45-degree field of view — 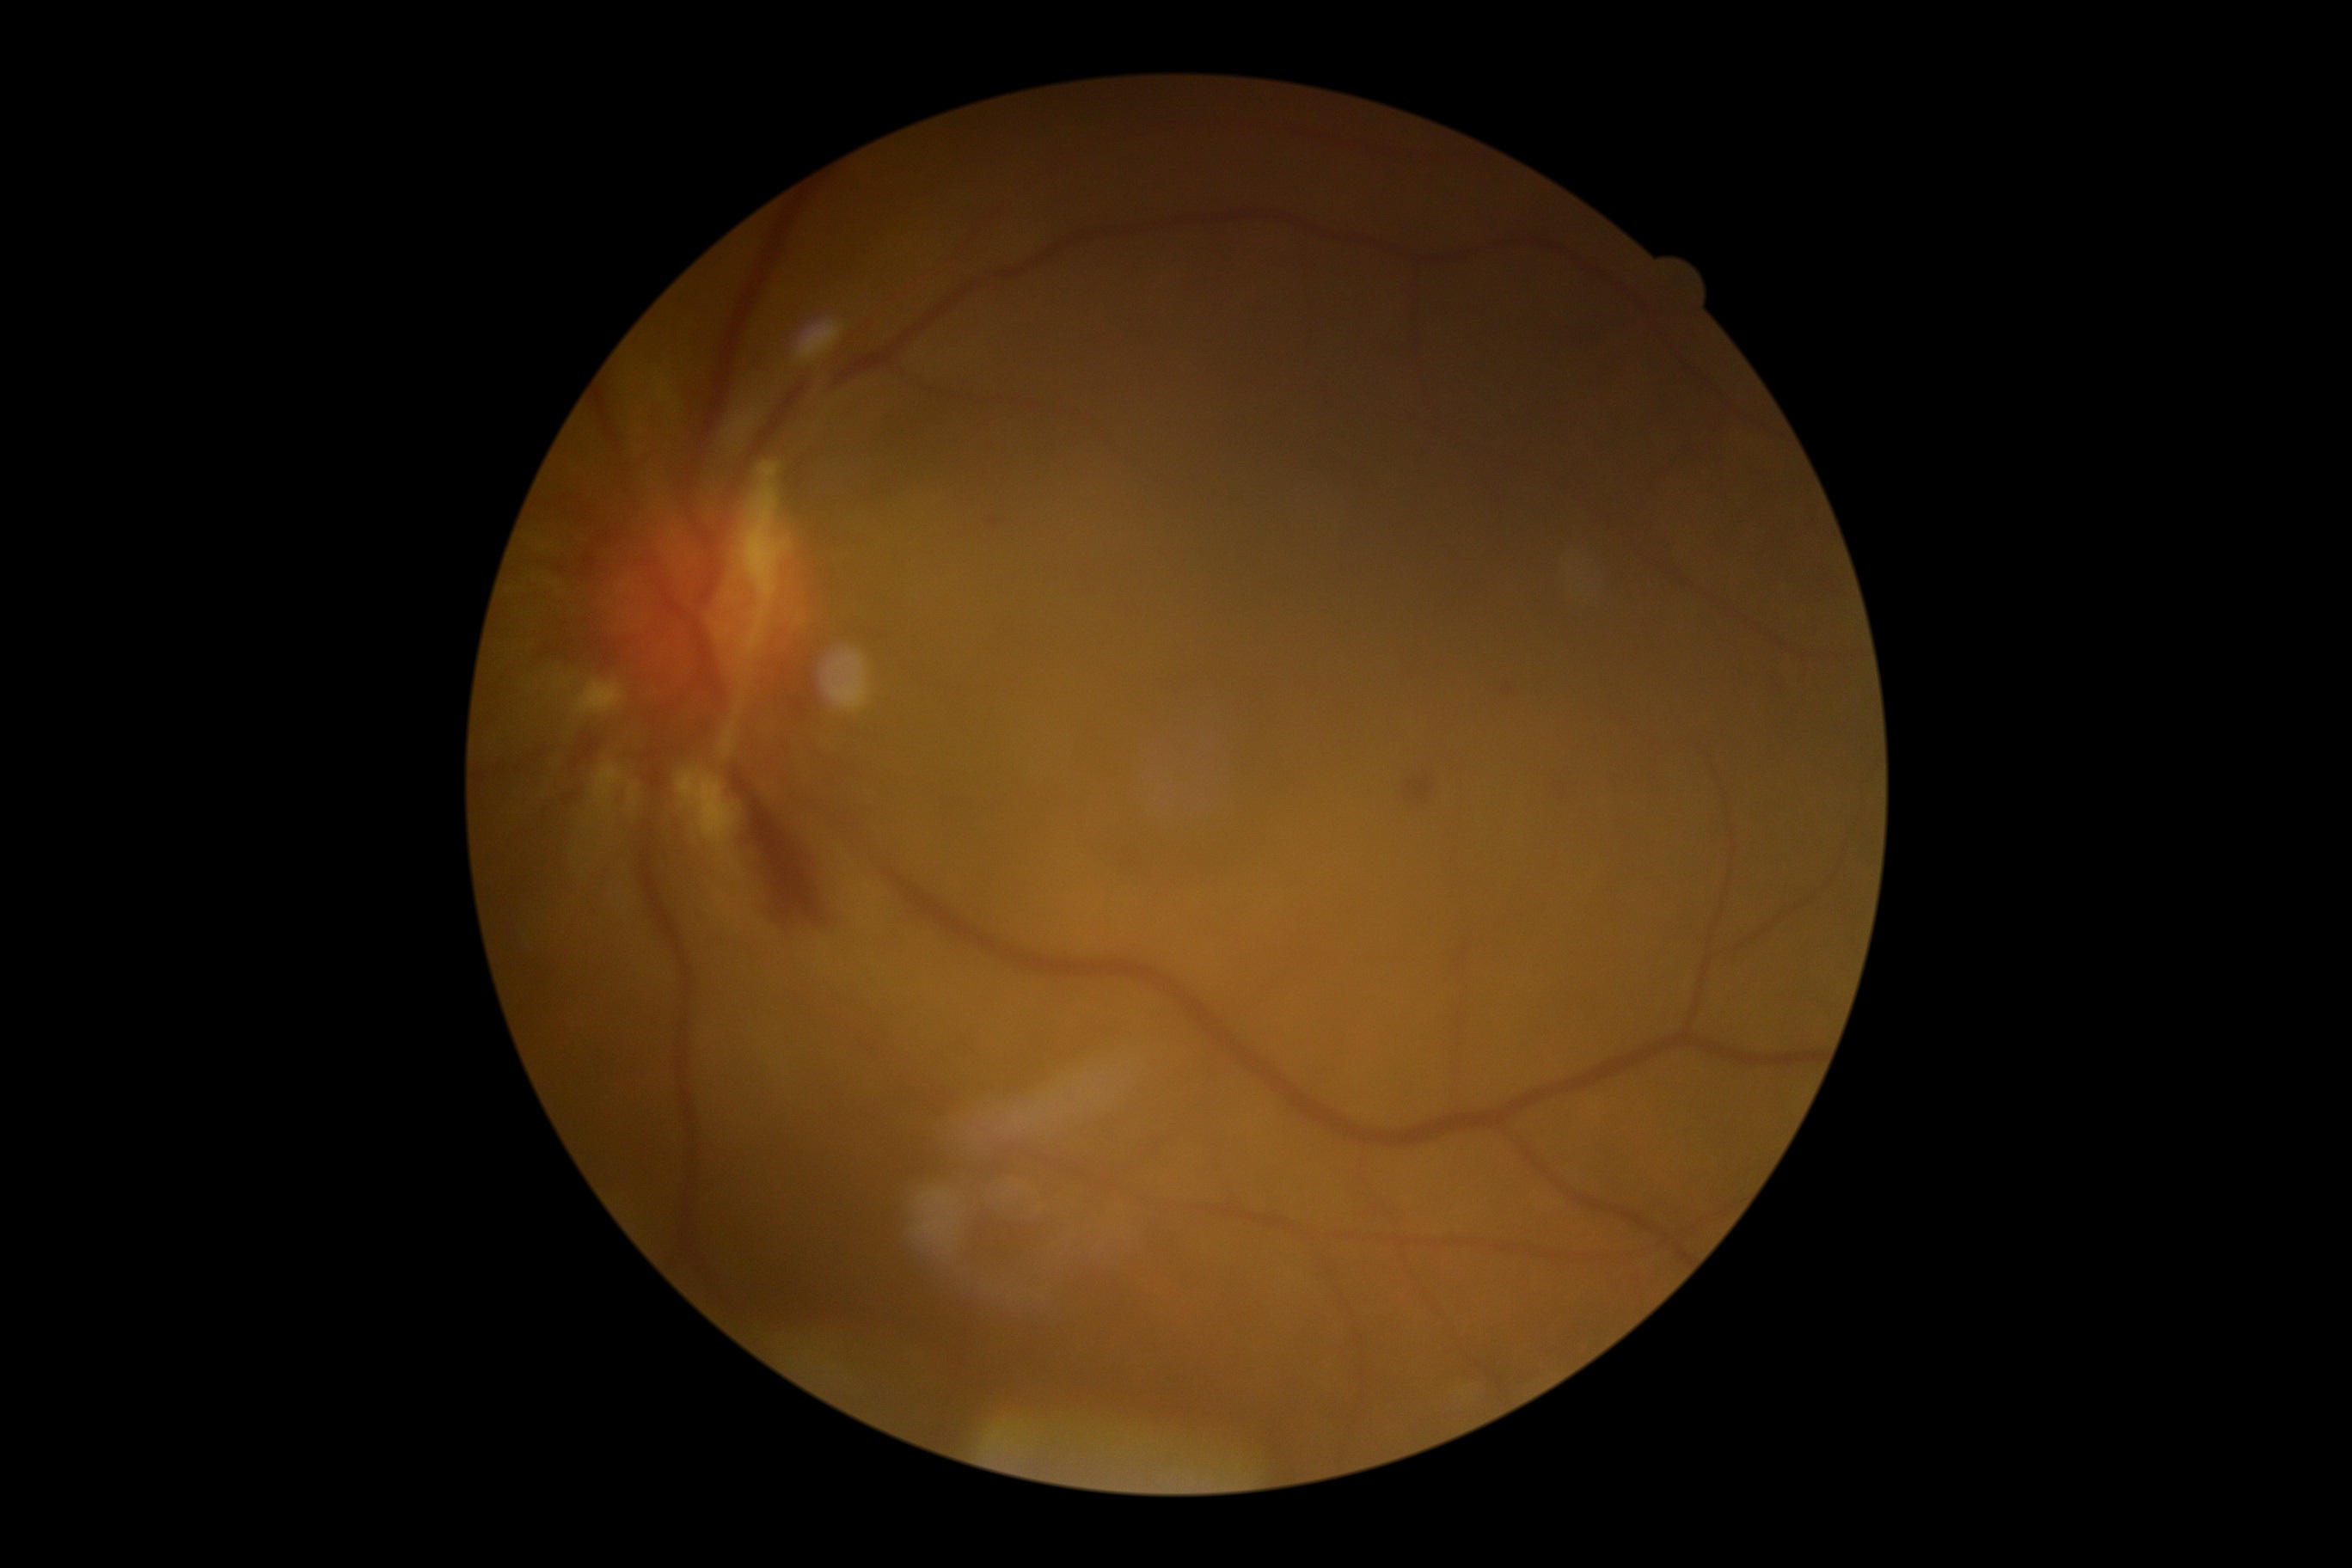 DR grade: proliferative diabetic retinopathy (4)
SEs: absent
EXs: absent
HEs: {"x1": 1404, "y1": 775, "x2": 1436, "y2": 807}, {"x1": 733, "y1": 771, "x2": 830, "y2": 928}, {"x1": 988, "y1": 518, "x2": 1005, "y2": 527}, {"x1": 1502, "y1": 683, "x2": 1514, "y2": 697}, {"x1": 570, "y1": 733, "x2": 601, "y2": 776}
Small HEs approximately at pt(1426, 773), pt(1563, 797), pt(1566, 788)
MAs: absent